Retinal fundus photograph, FOV: 45 degrees, 2212x1659px
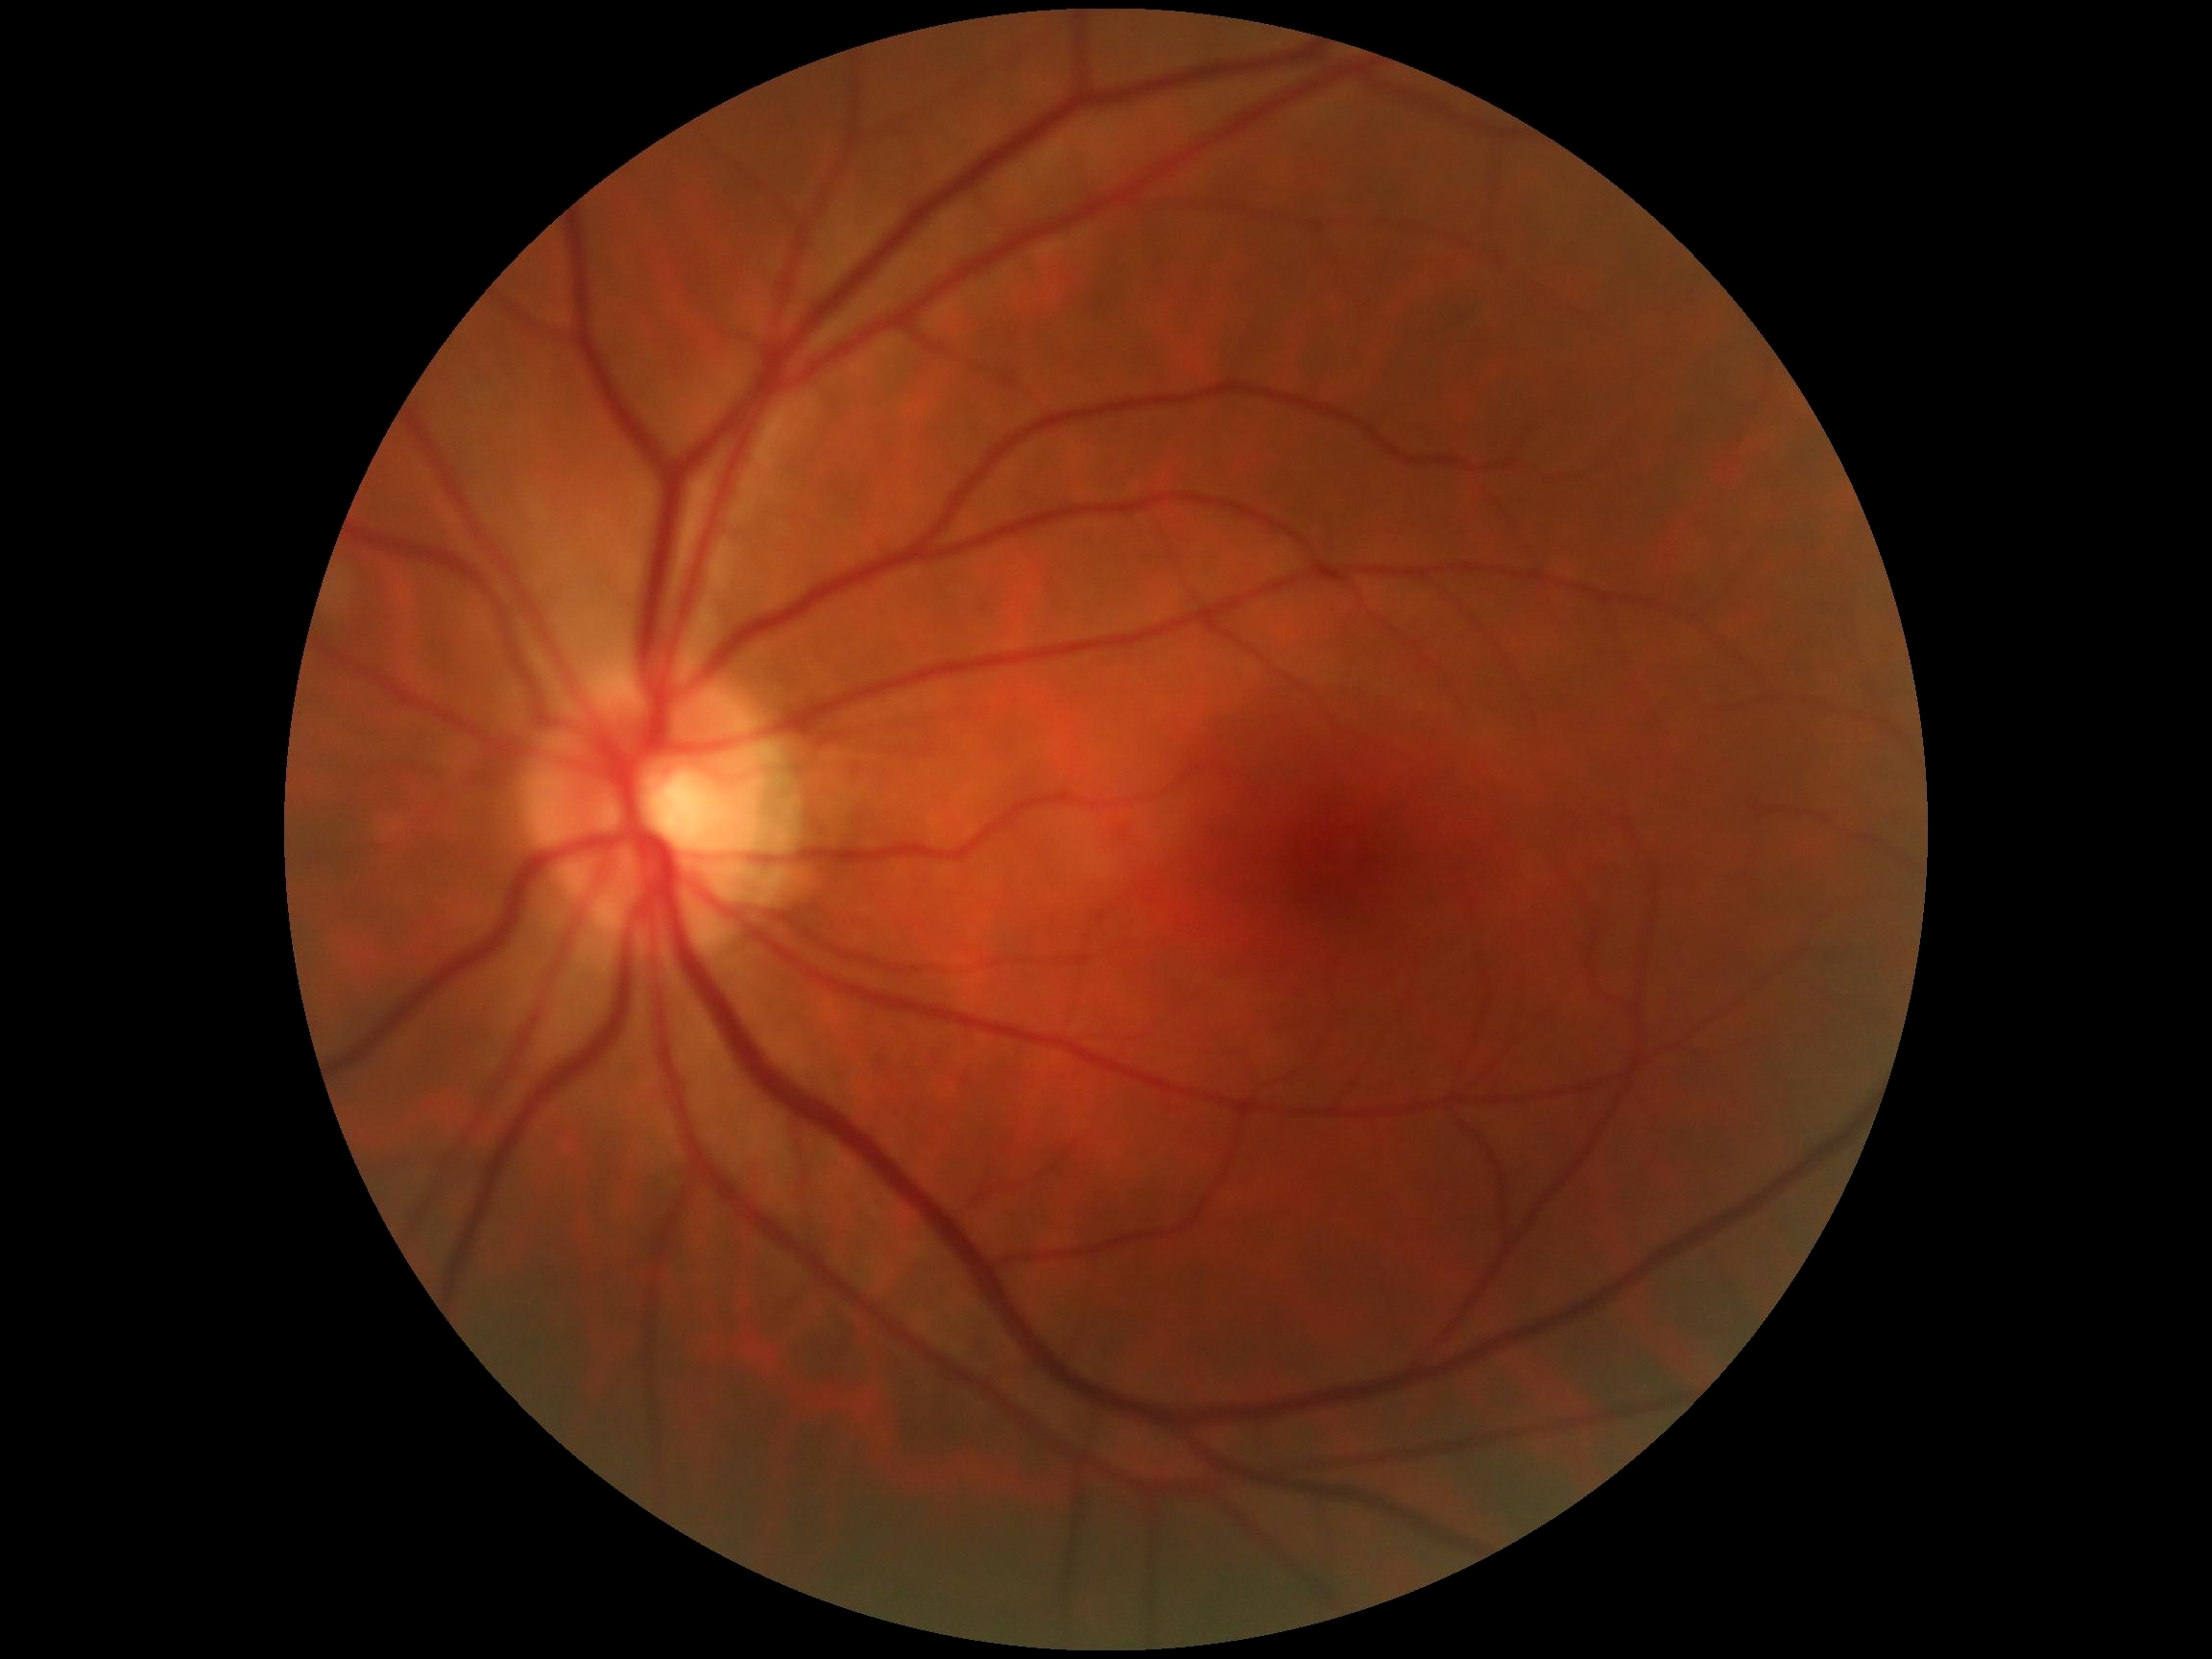 DR grade: 0.